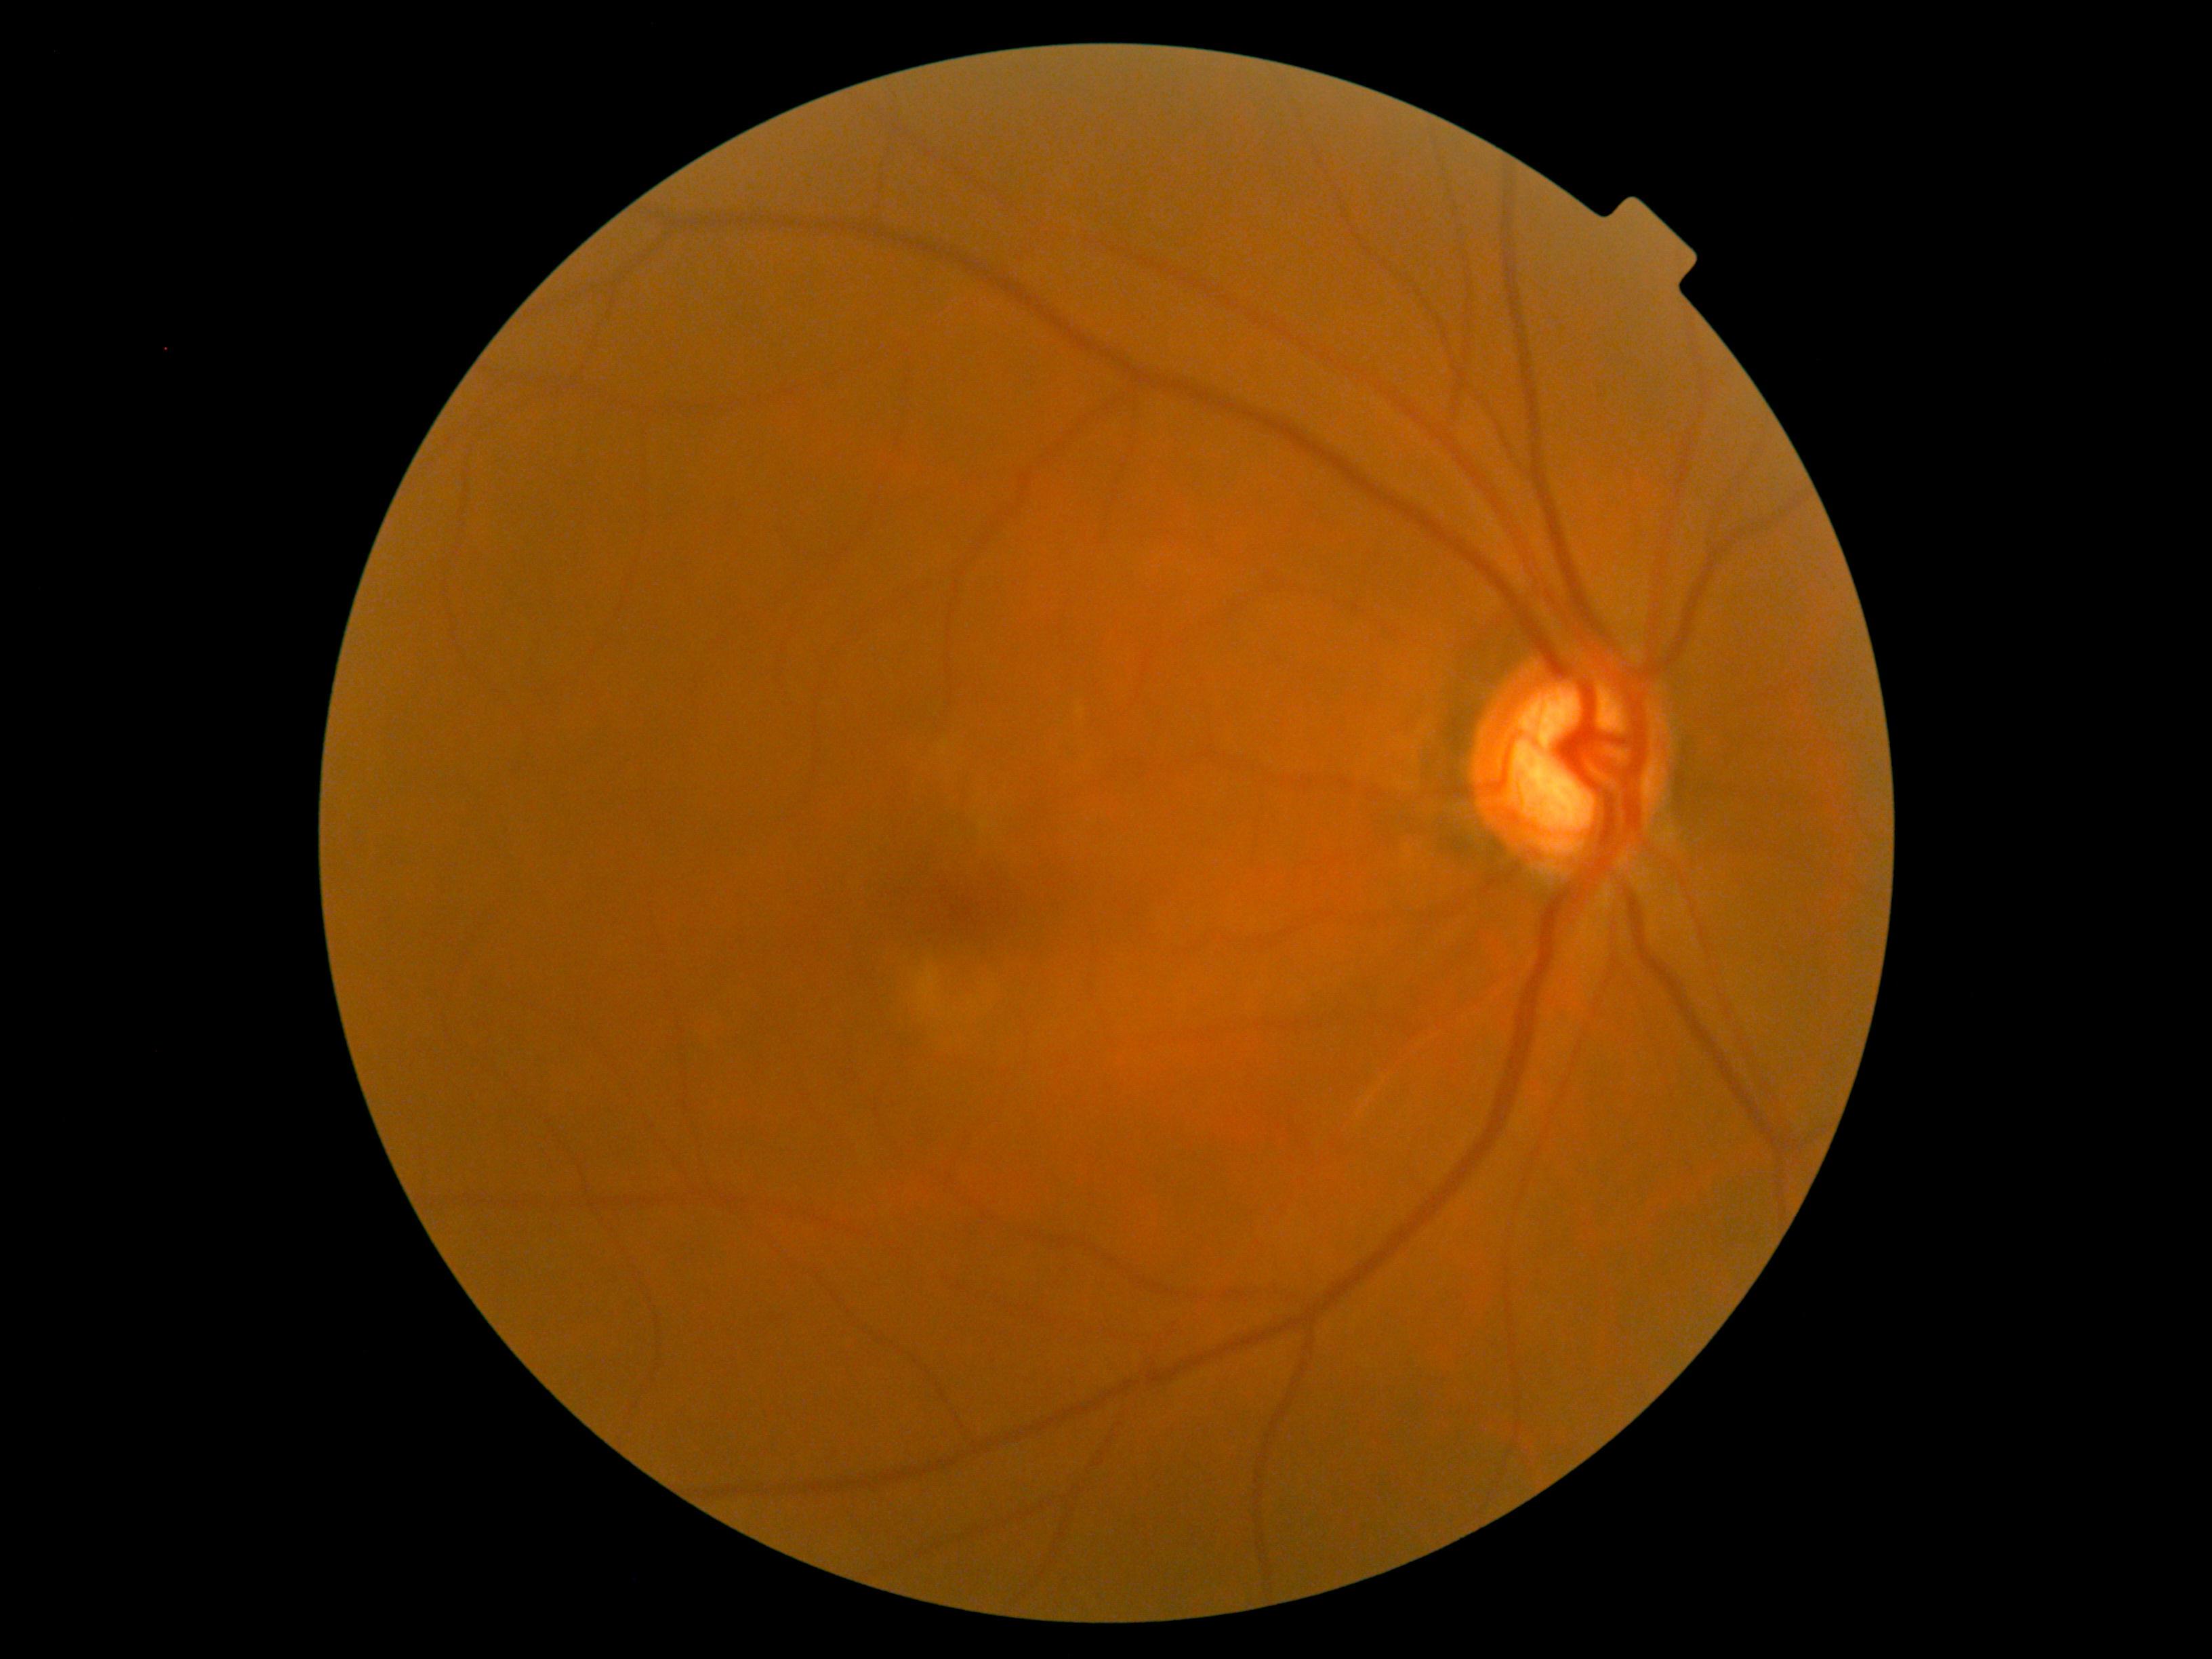
DR stage: grade 0 (no apparent retinopathy).